Wide-field fundus image from infant ROP screening. Camera: Clarity RetCam 3 (130° FOV). 640x480px.
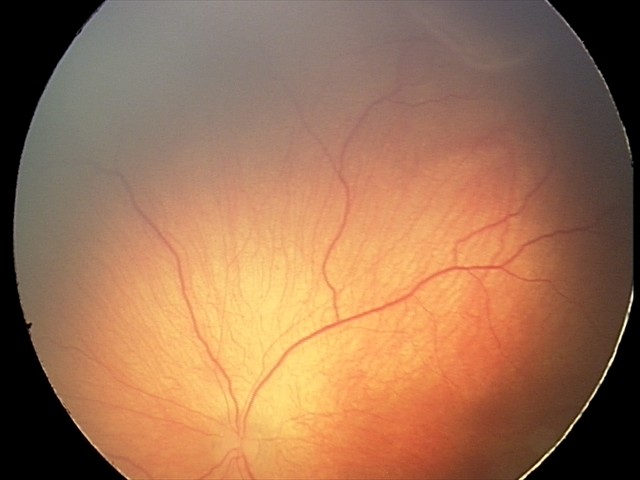 Q: What is the diagnosis from this examination?
A: ROP stage 2
Q: What is the plus-form classification?
A: no plus disease